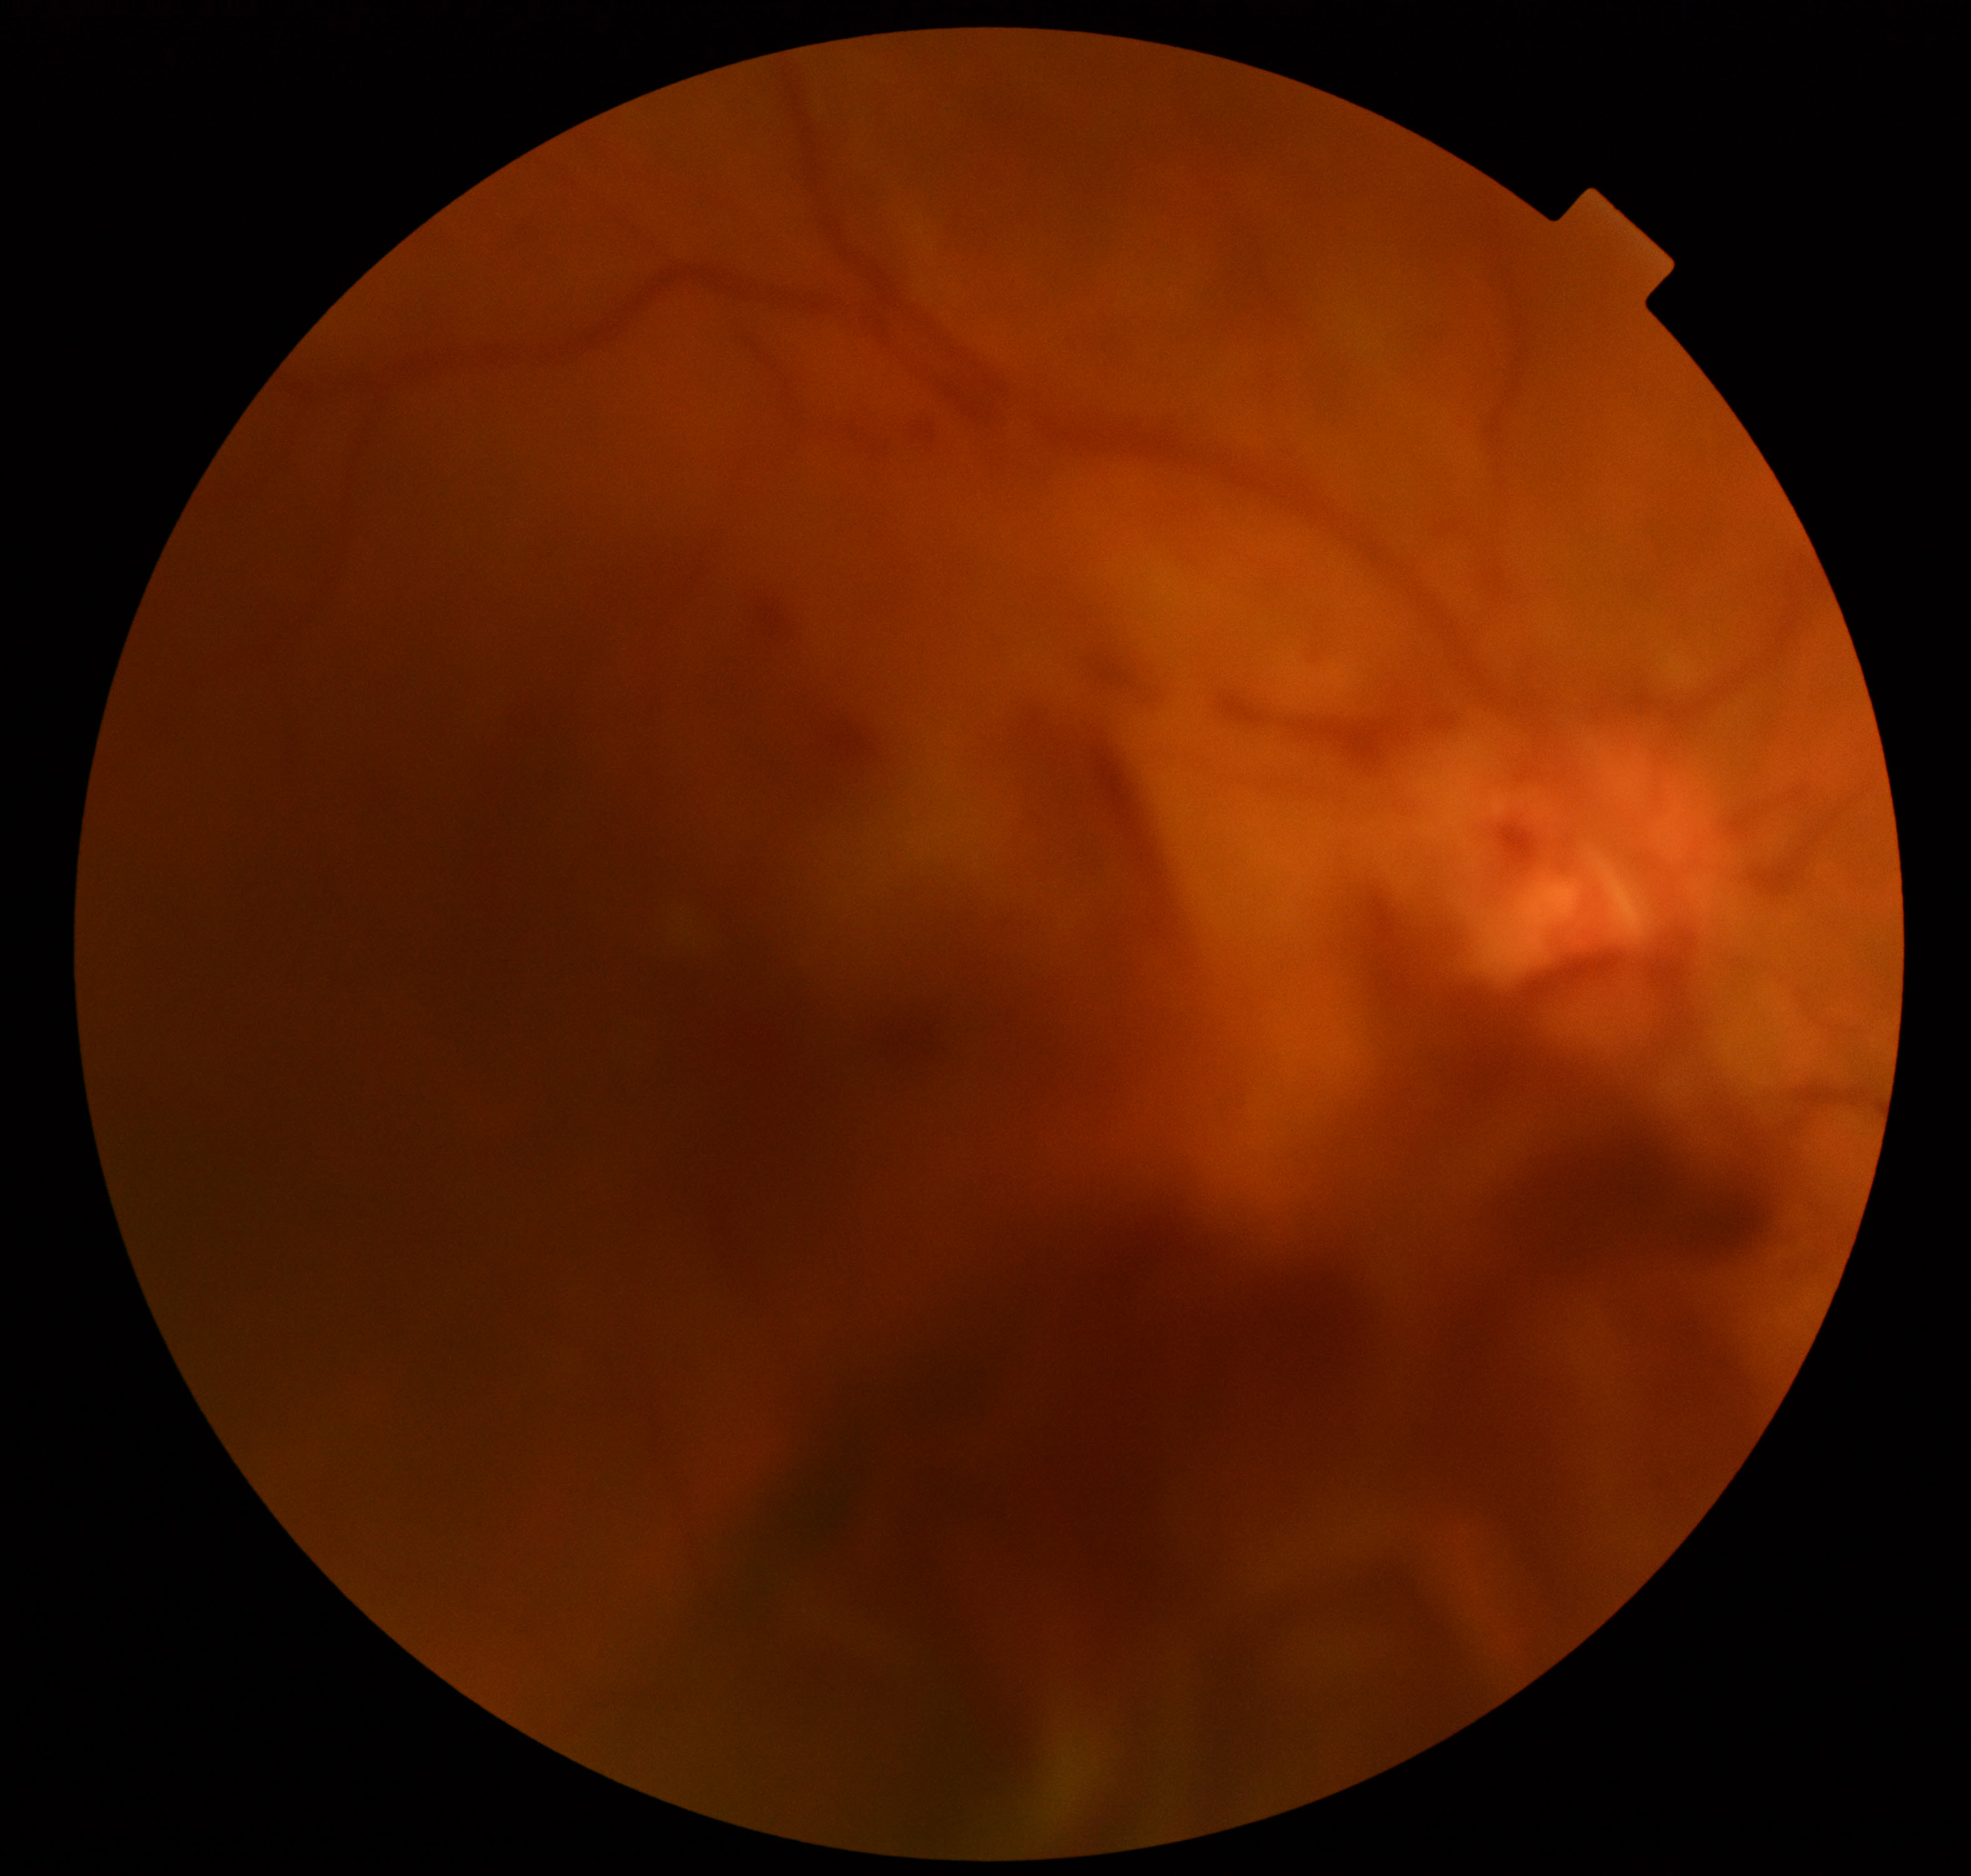
Gradability: blurred, more than half the field obscured.
Proliferative retinopathy: suspected.